Disc-centered field — 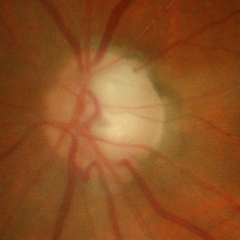

Glaucomatous optic neuropathy is present. Color fundus photograph showing early glaucoma.